Color fundus image, FOV: 45 degrees: 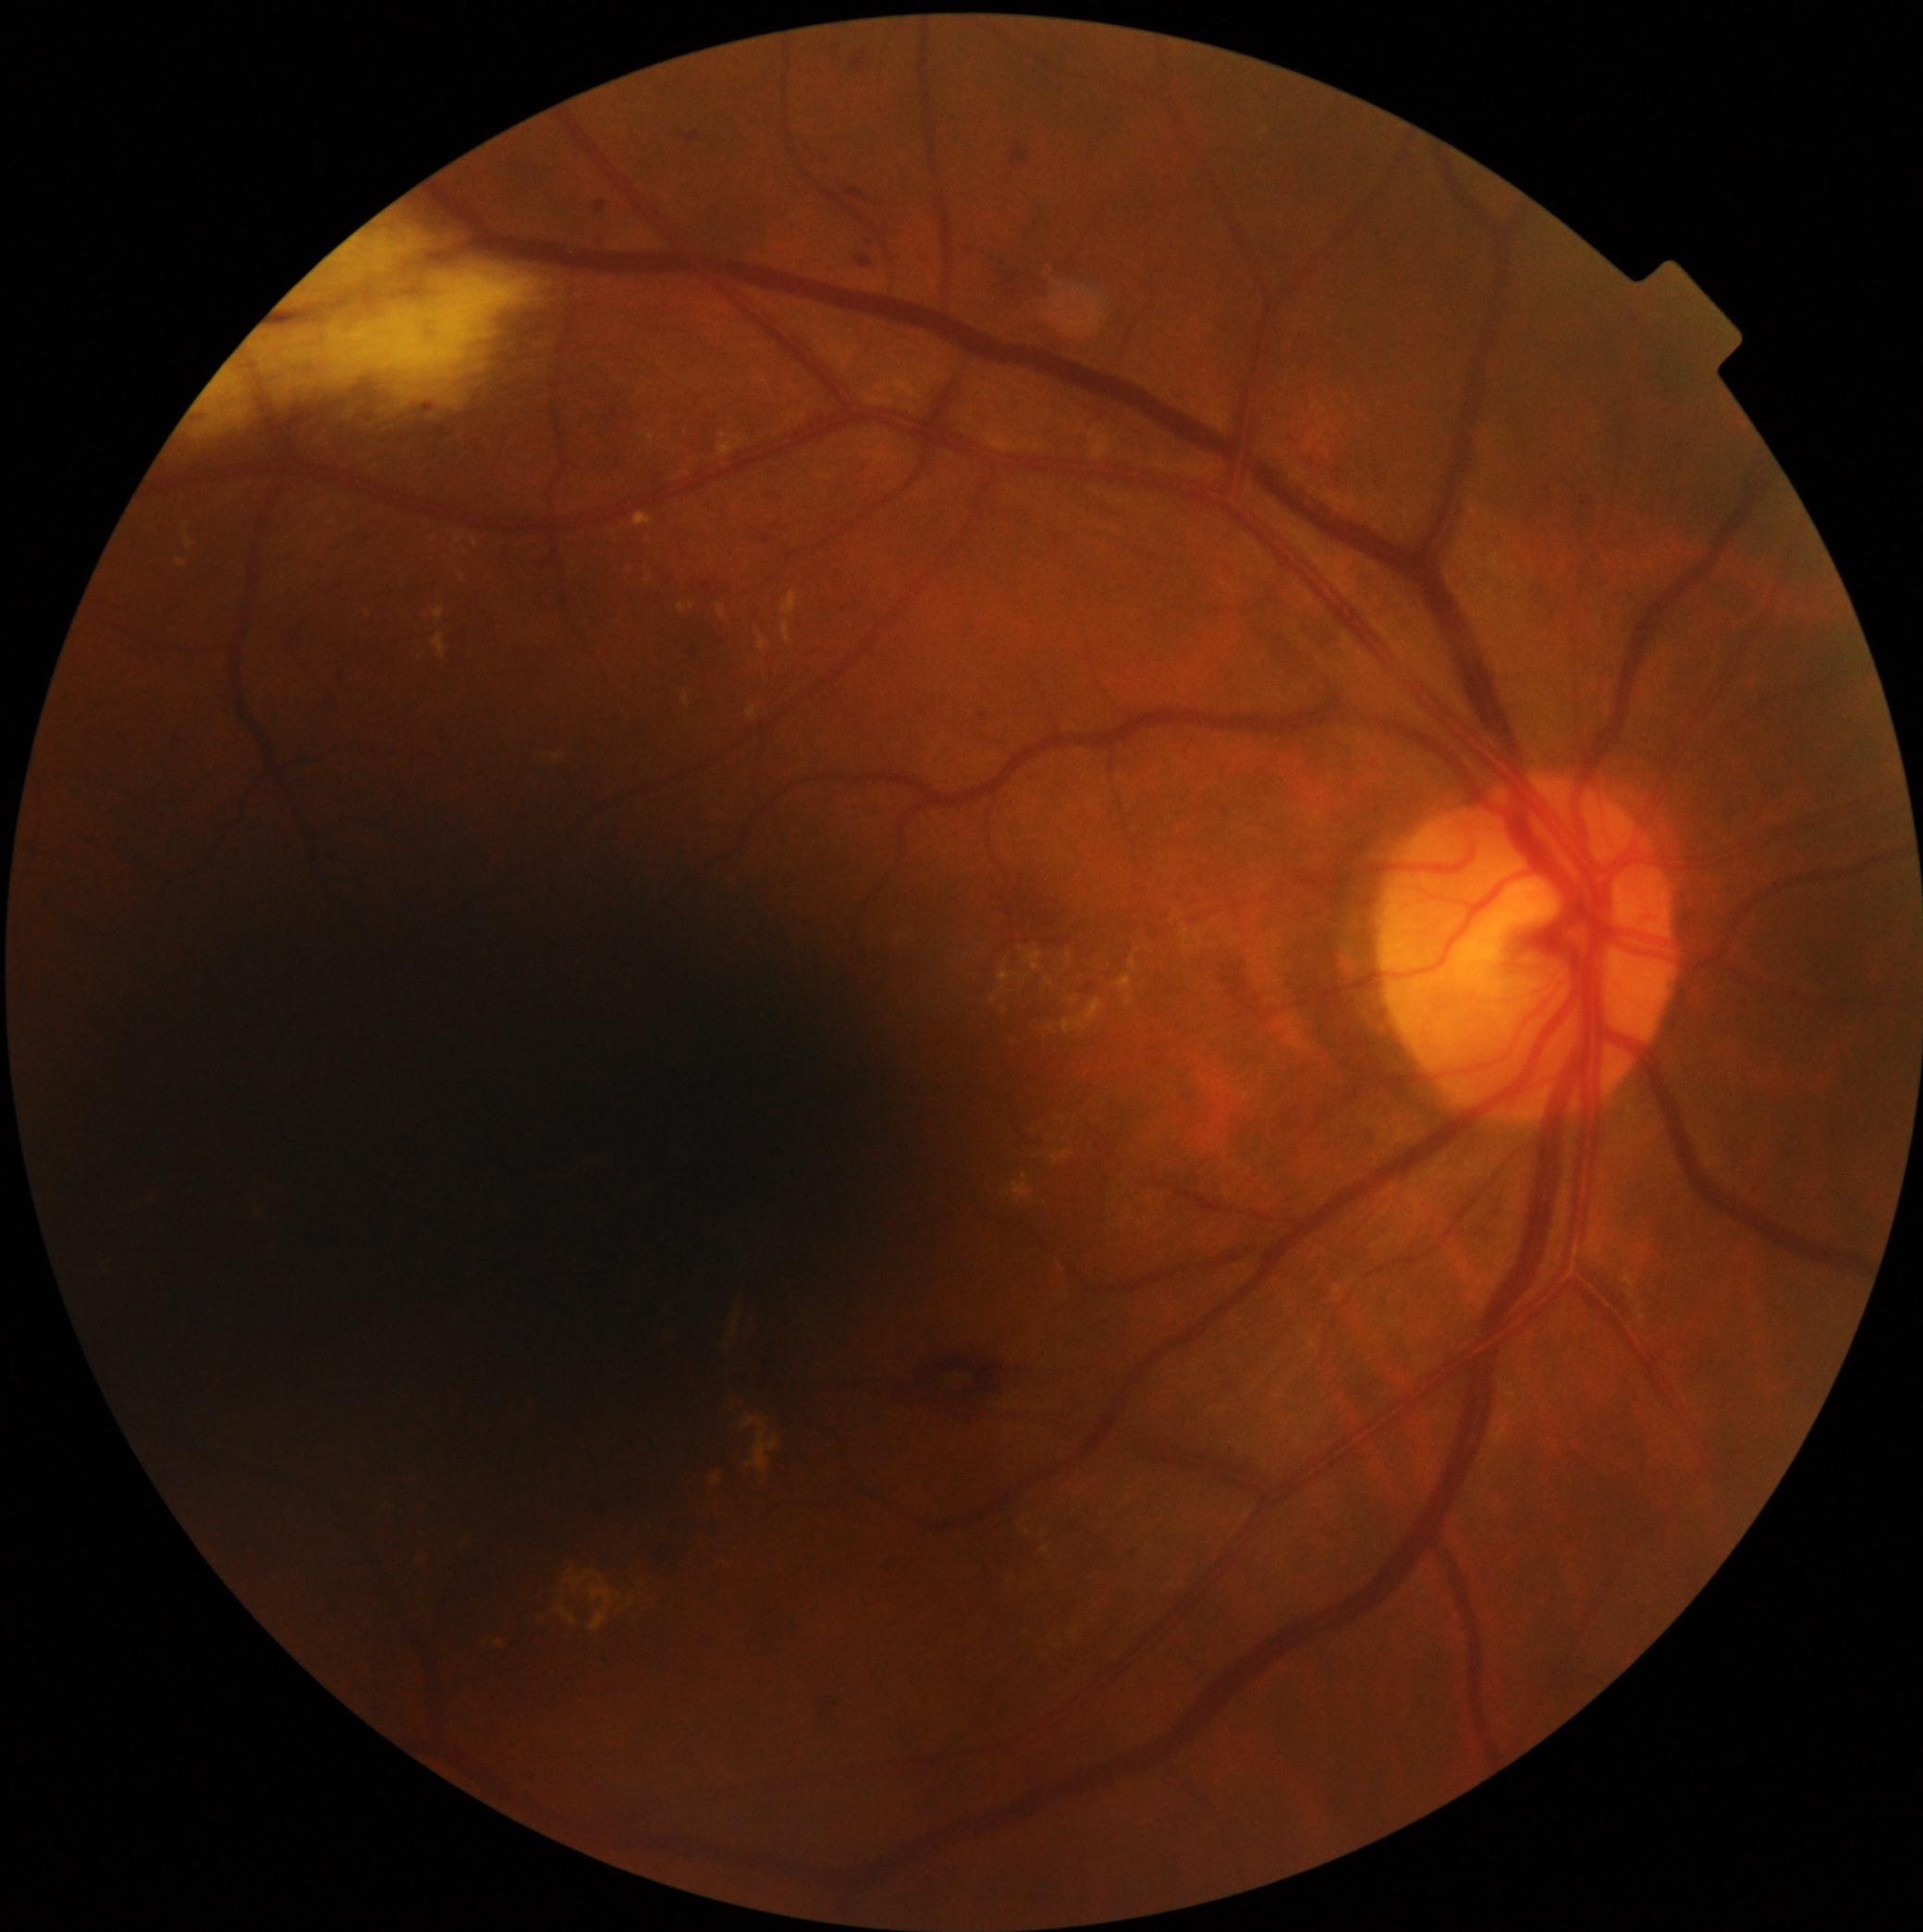

DR severity is 2.